Color fundus image — 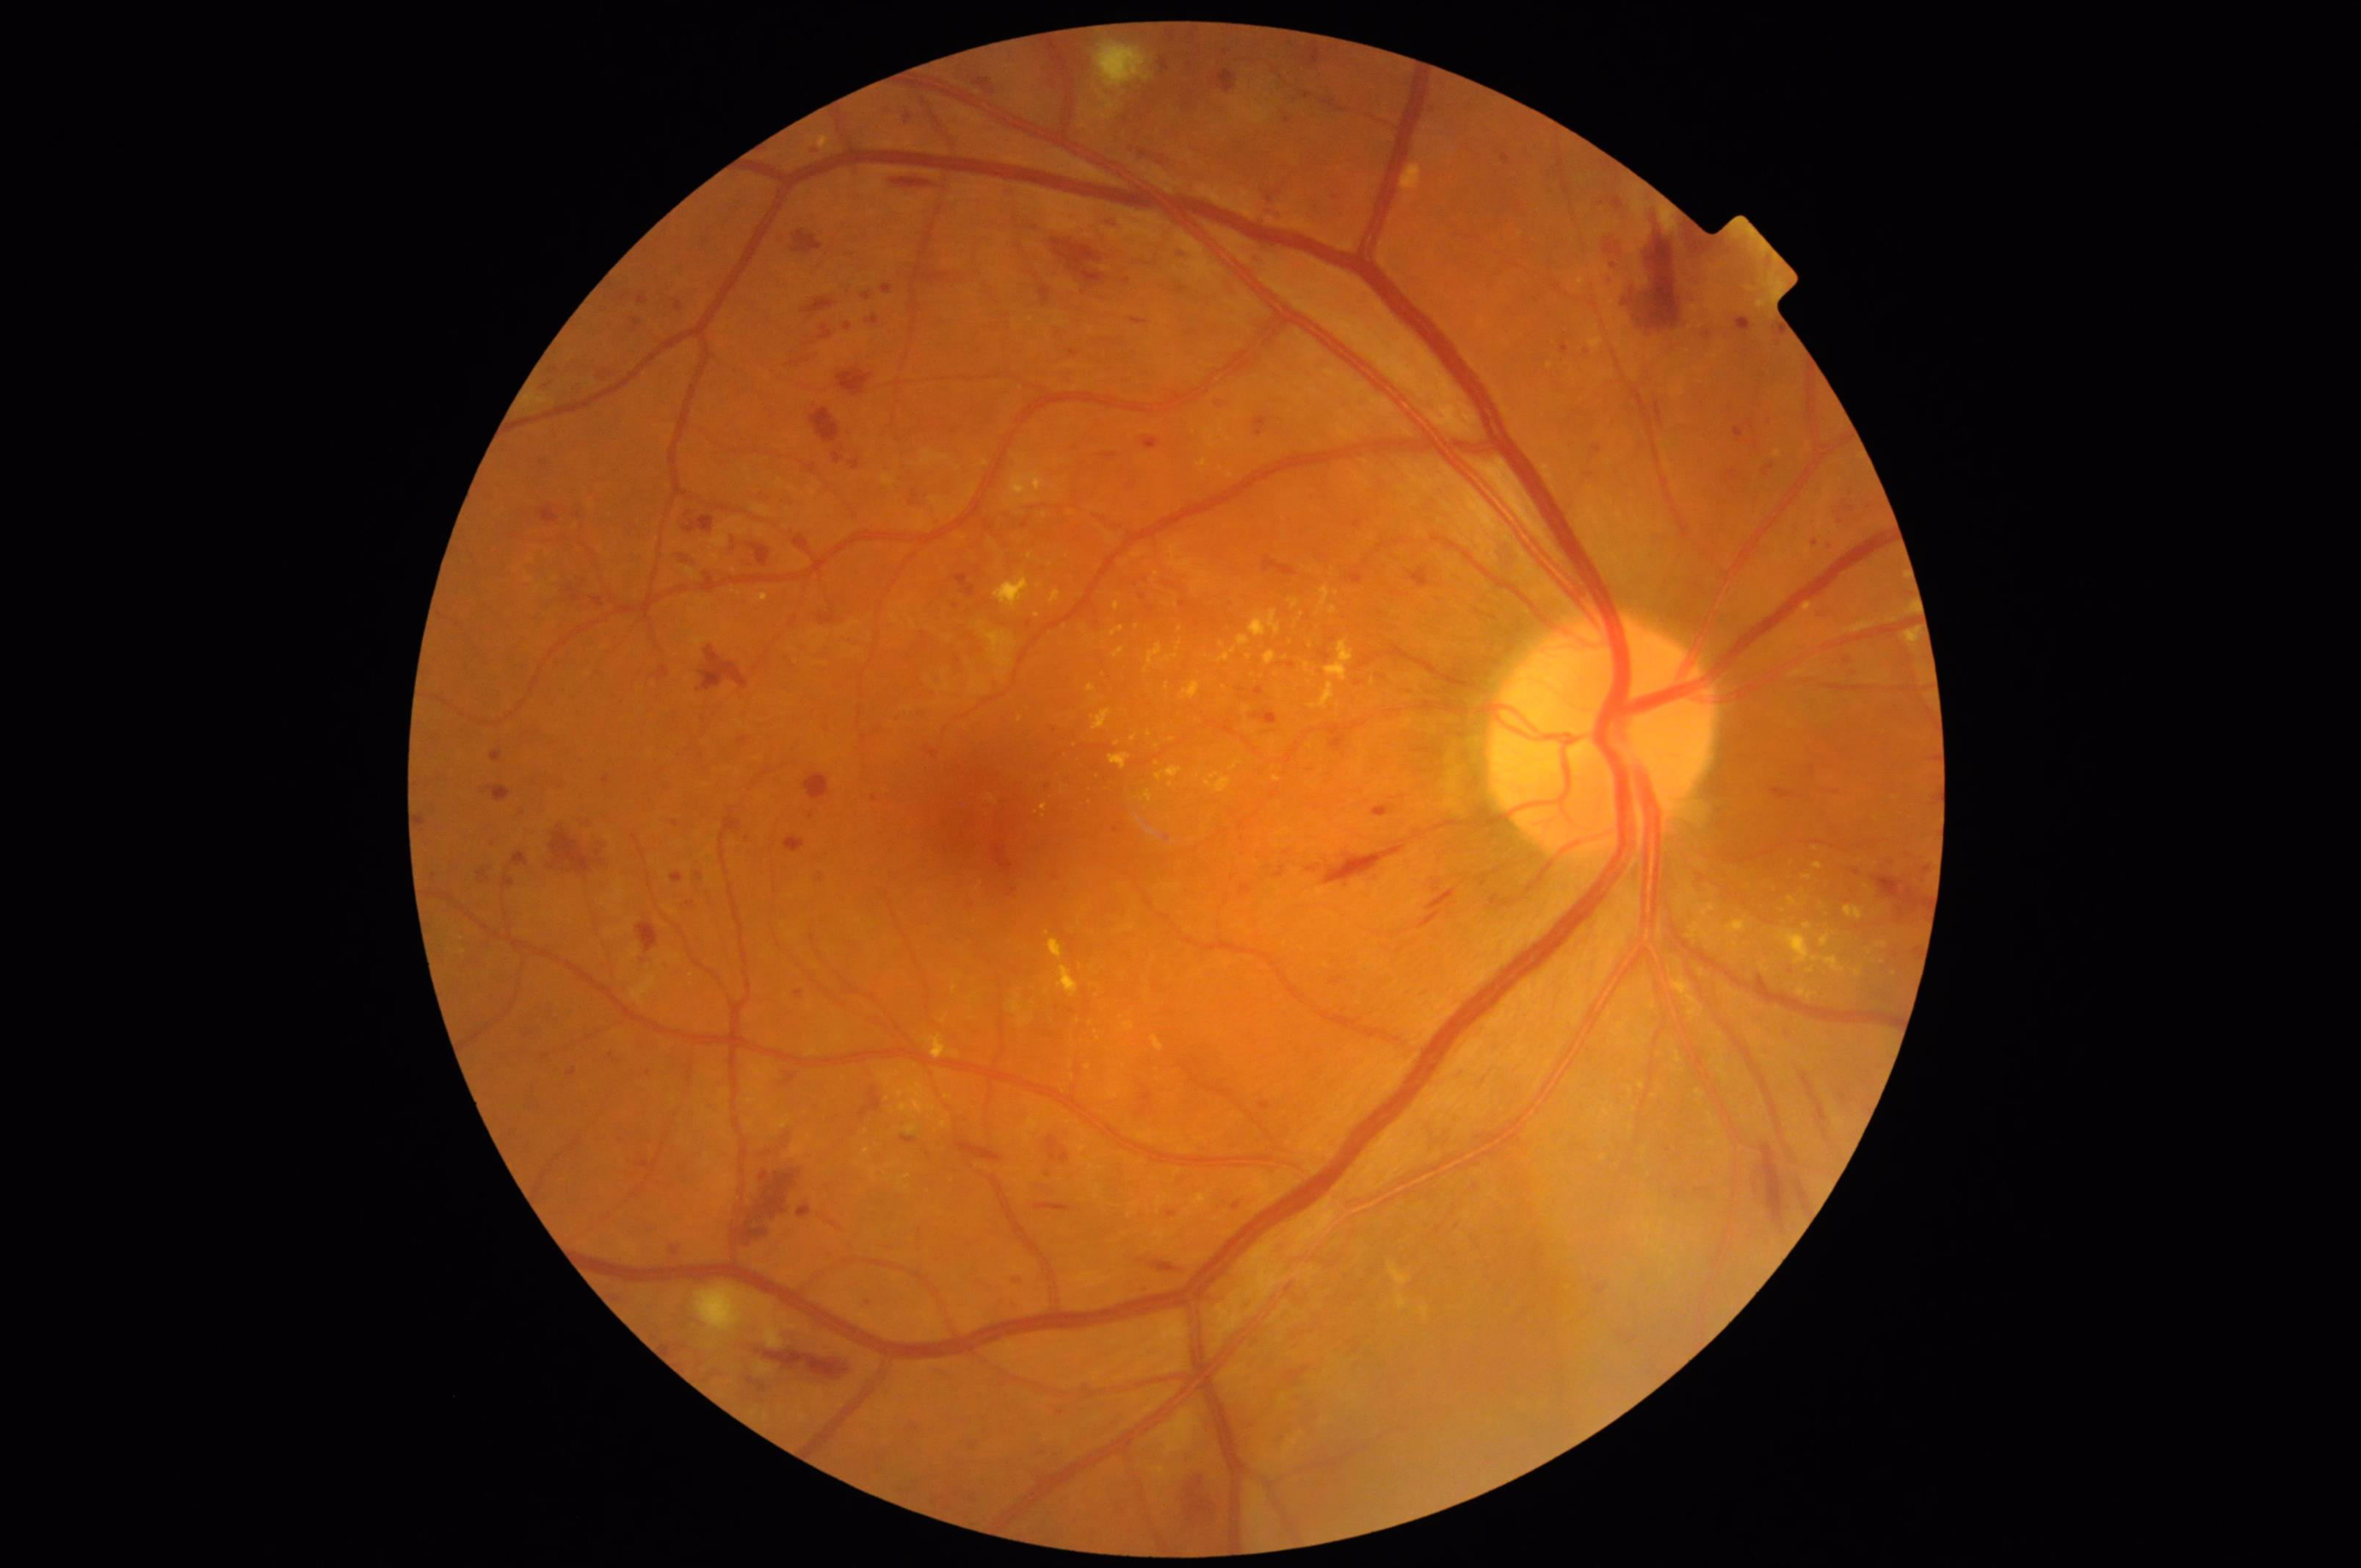

{
  "overall_quality": "good, gradable",
  "clarity": "sharp throughout the field",
  "contrast": "wide intensity range, structures distinguishable",
  "illumination": "no over- or under-exposure"
}